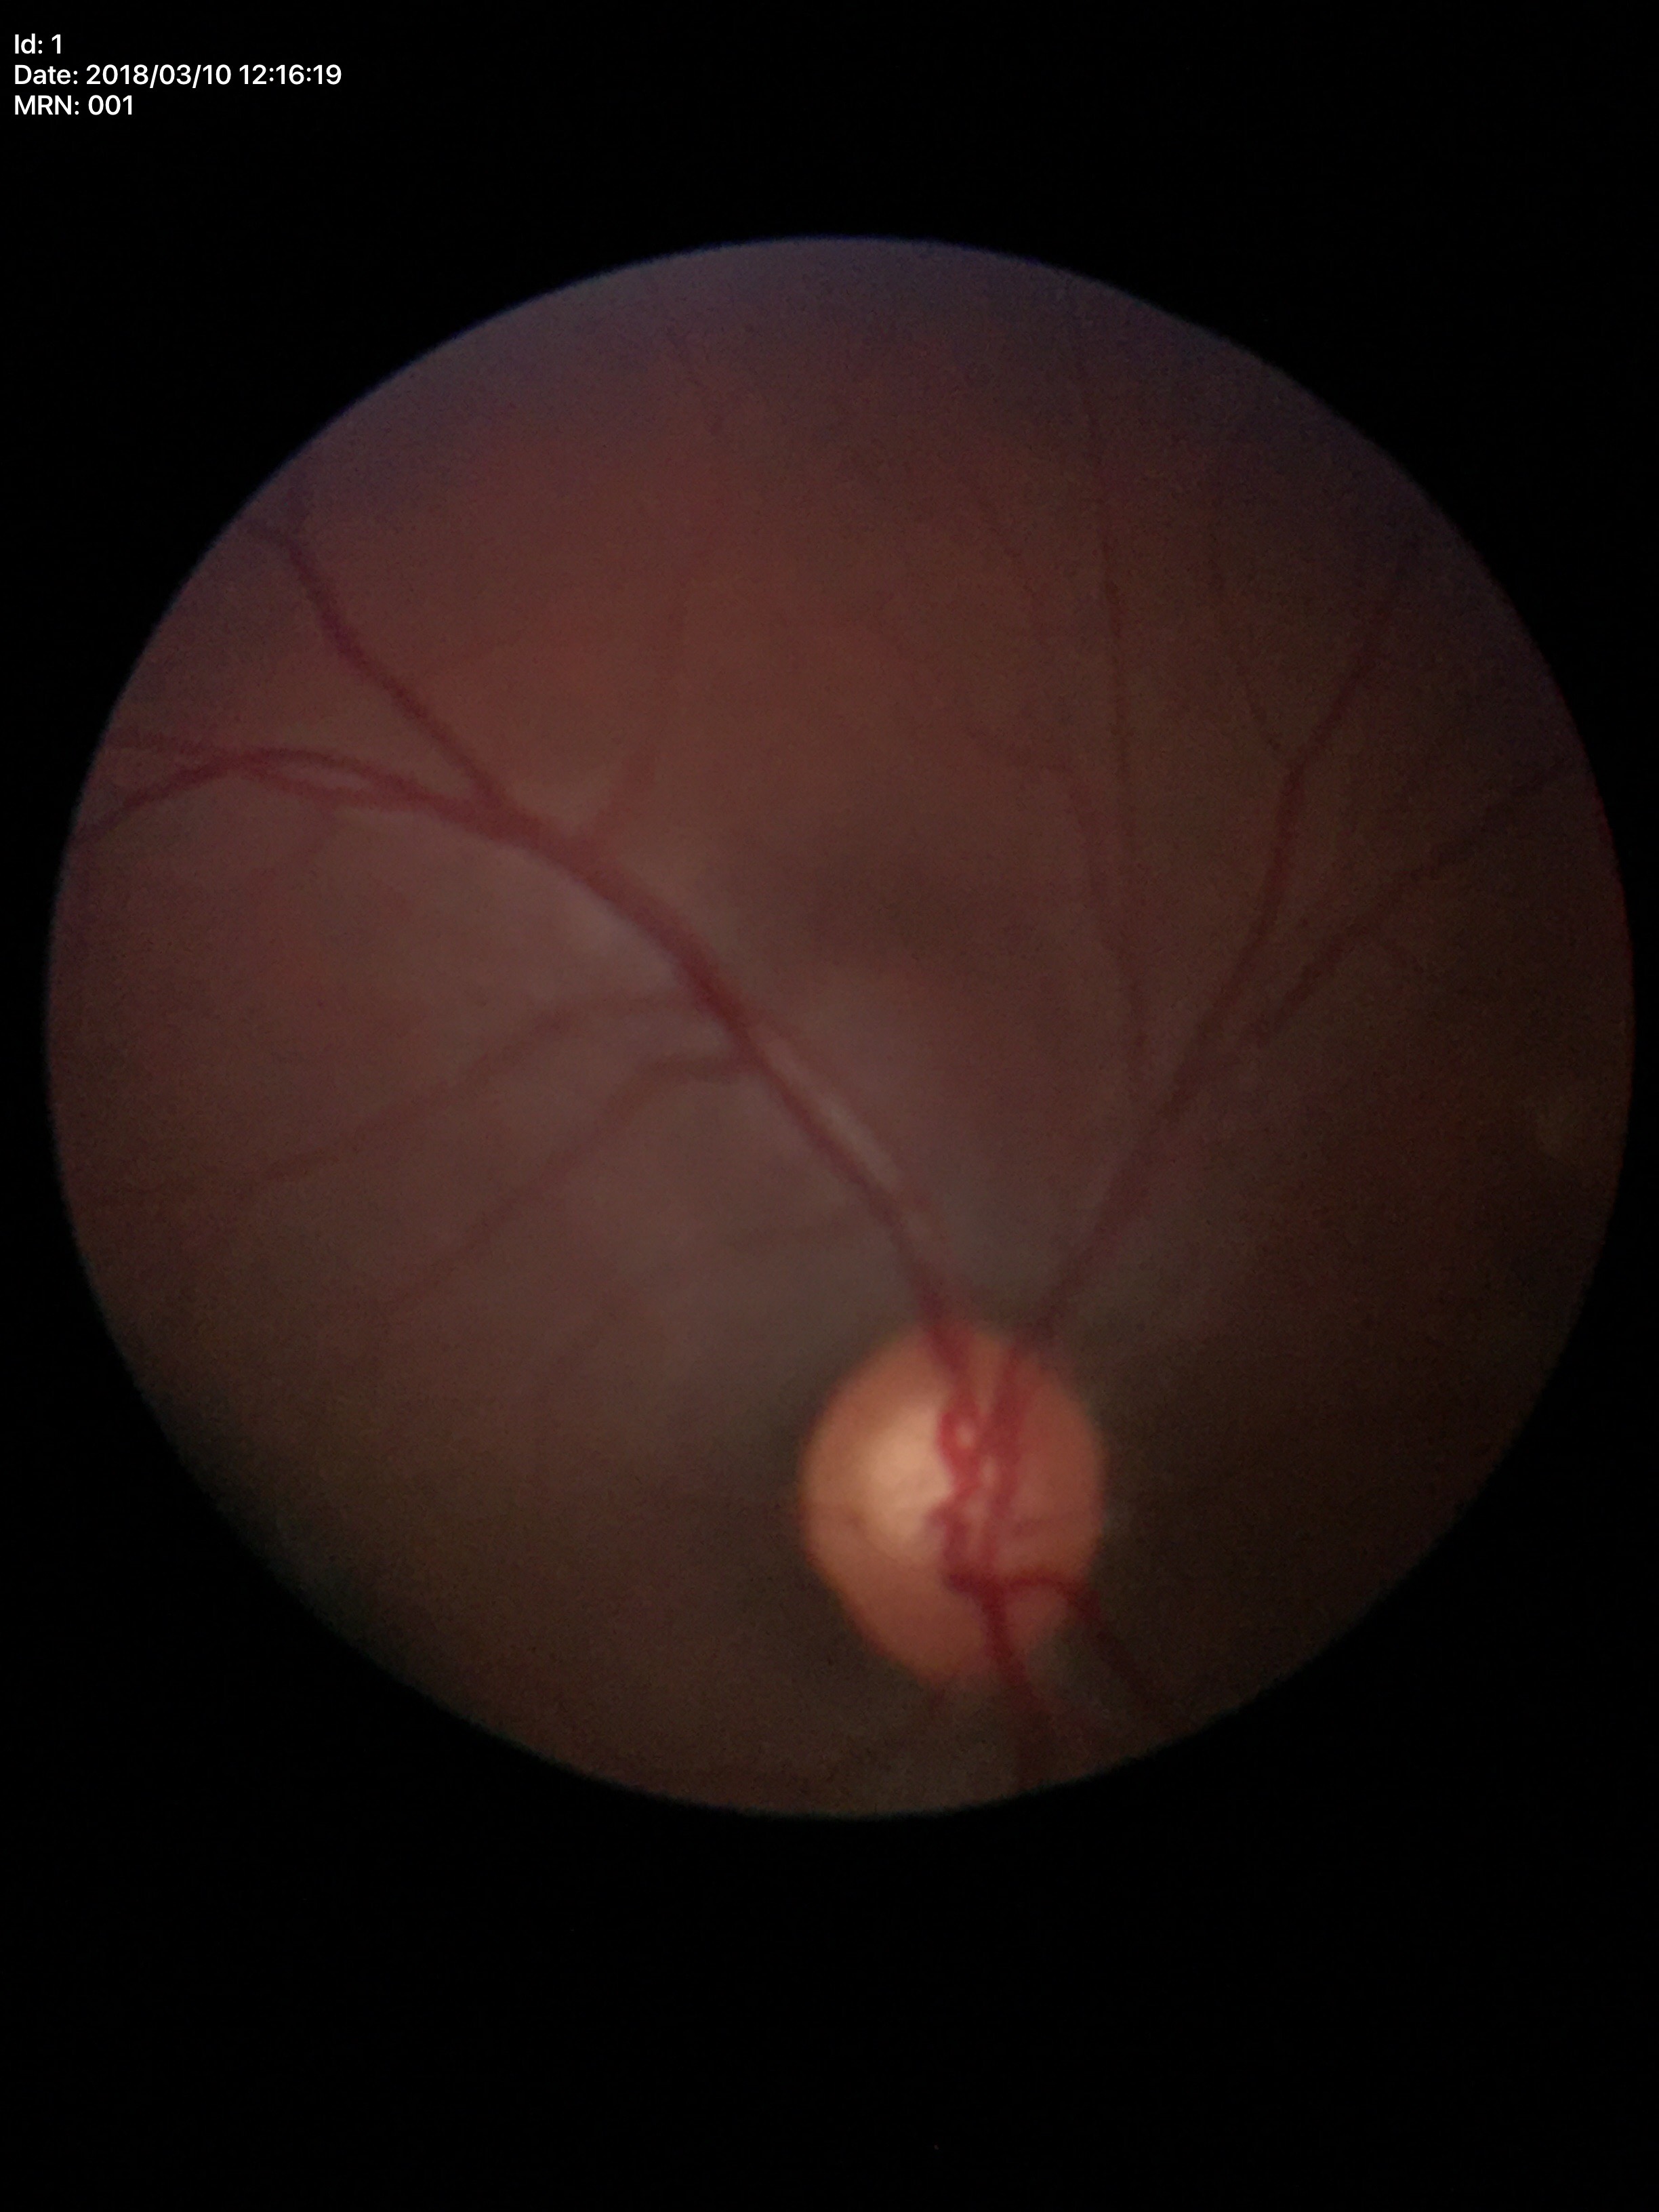

Q: What is the glaucoma assessment?
A: suspicious findings
Q: What is the ACDR?
A: 0.36
Q: Vertical CDR?
A: 0.59